Acquired with a Topcon TRC-50DX · color fundus image: 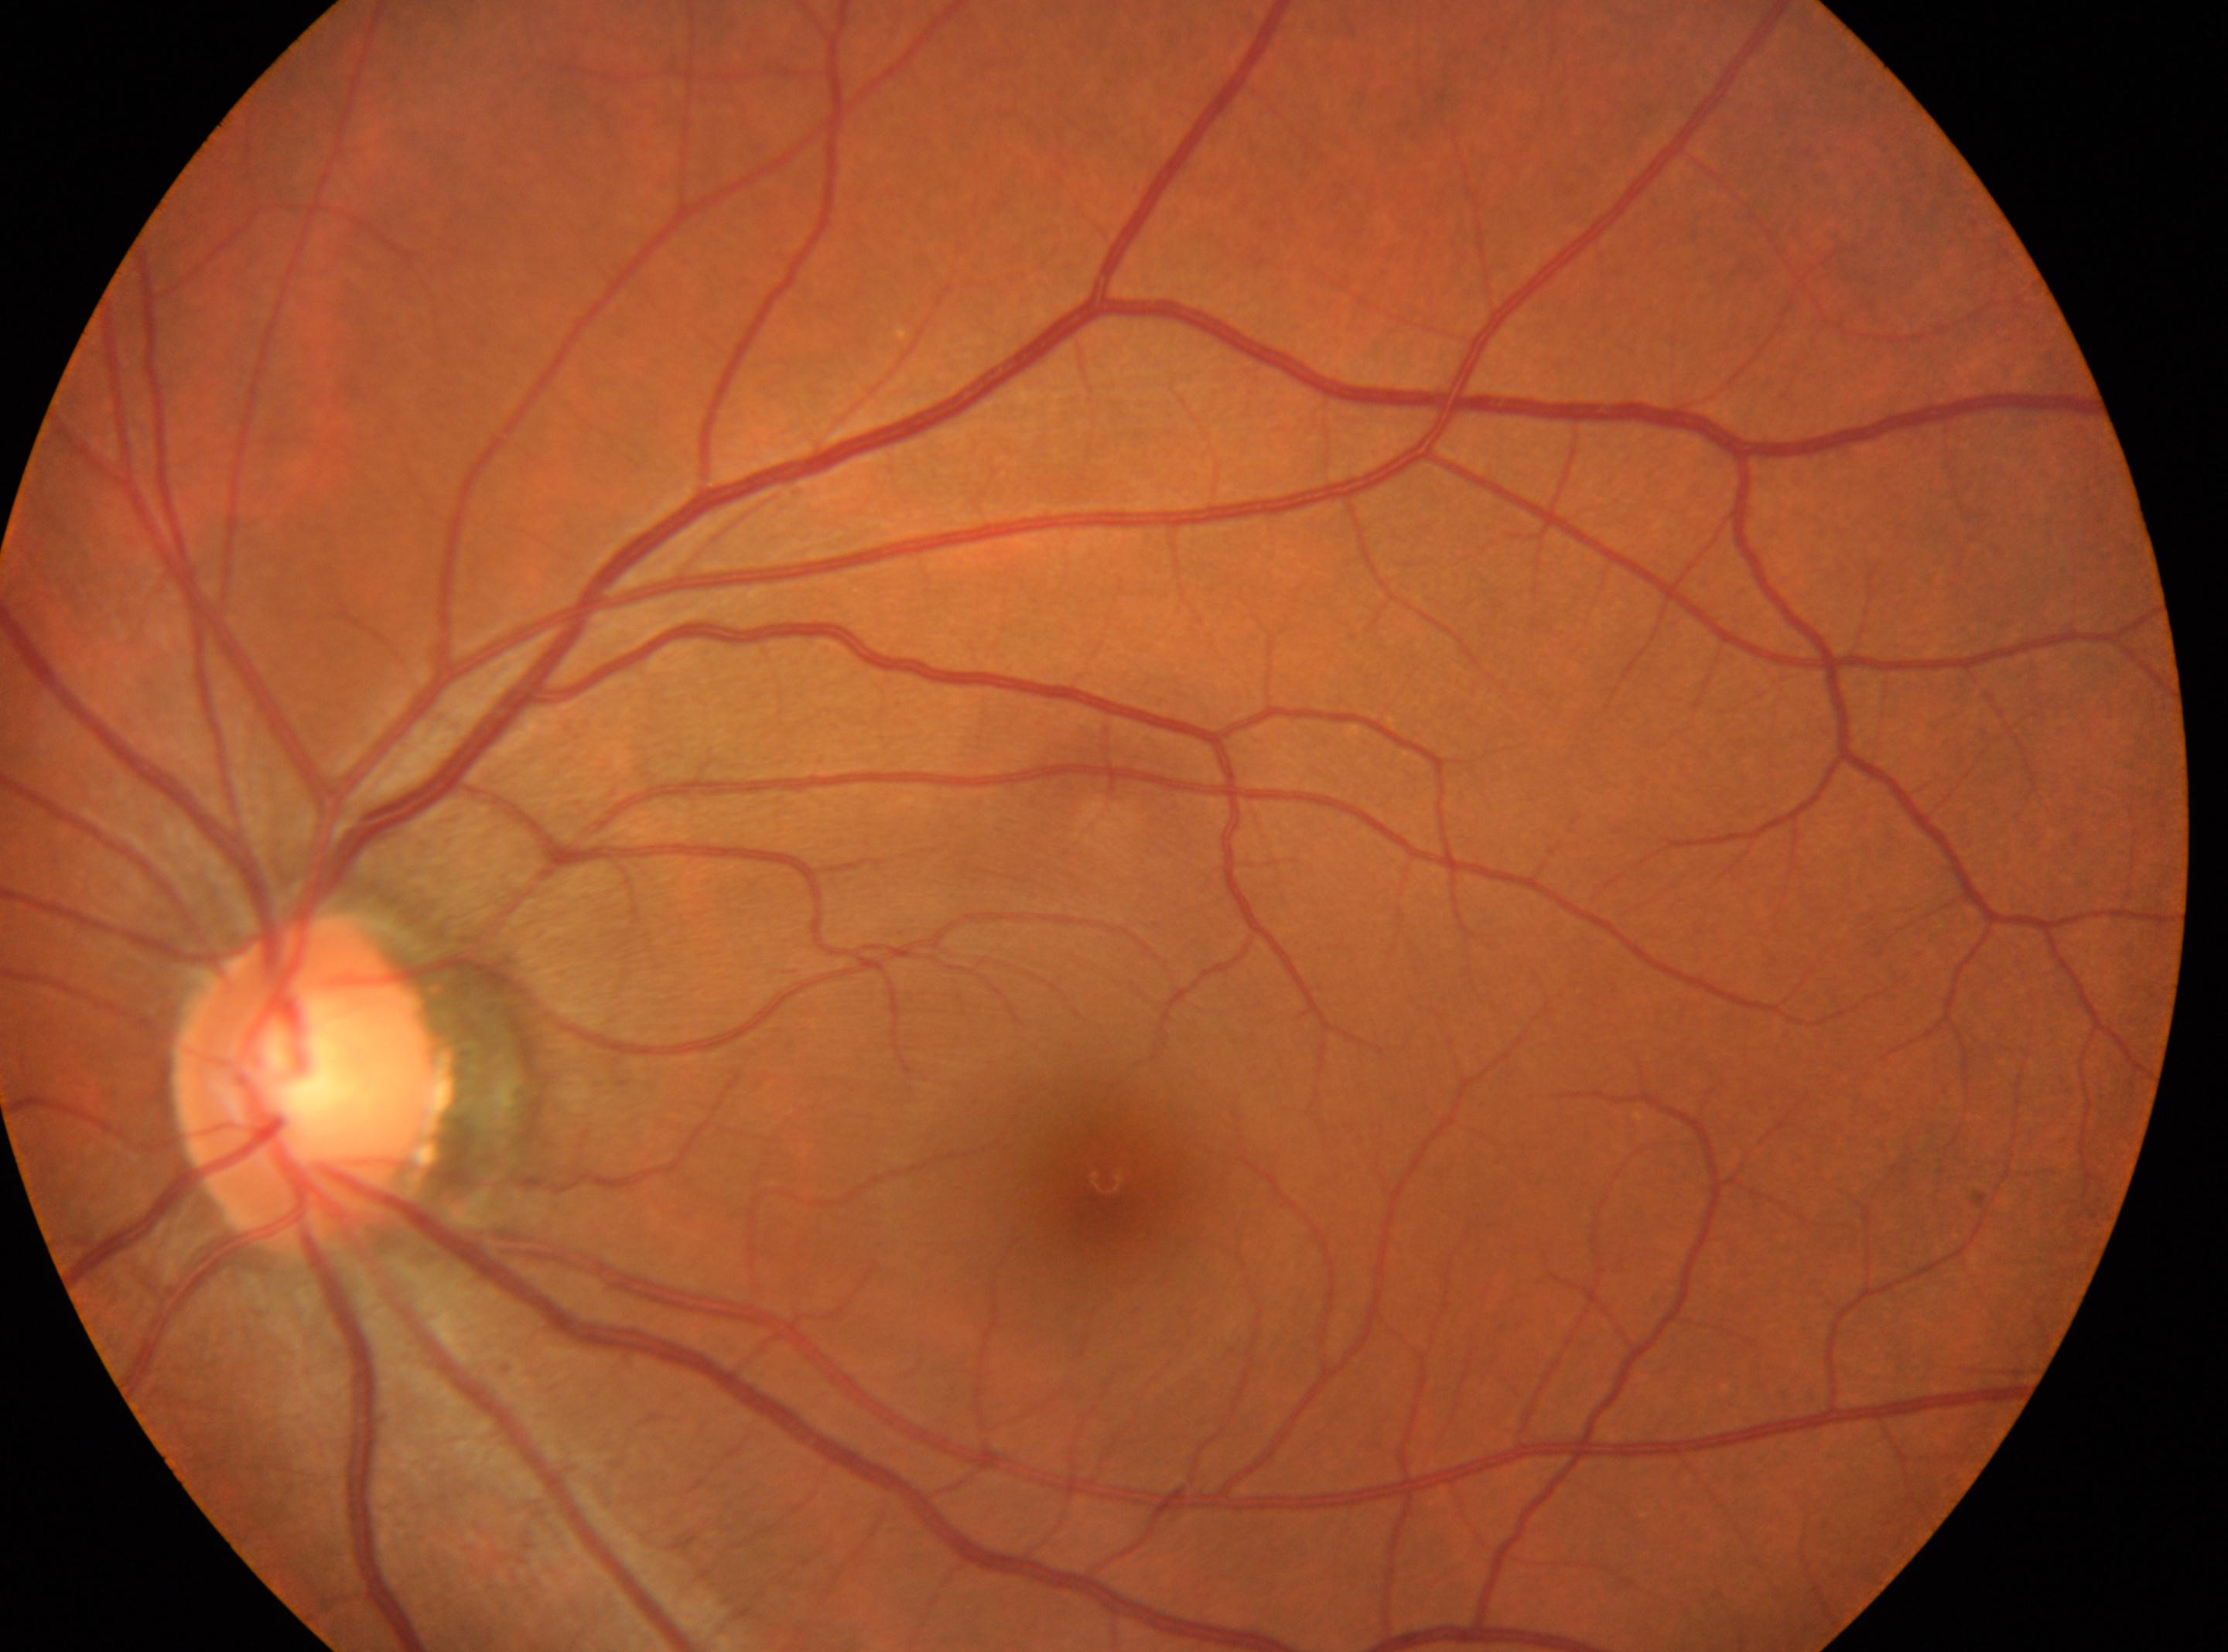 Macular center located at x=1103, y=1179. Eye: left. Diabetic retinopathy is grade 0 — no visible signs of diabetic retinopathy. The optic disc is at x=311, y=1087.